Modified Davis classification, color fundus image, NIDEK AFC-230.
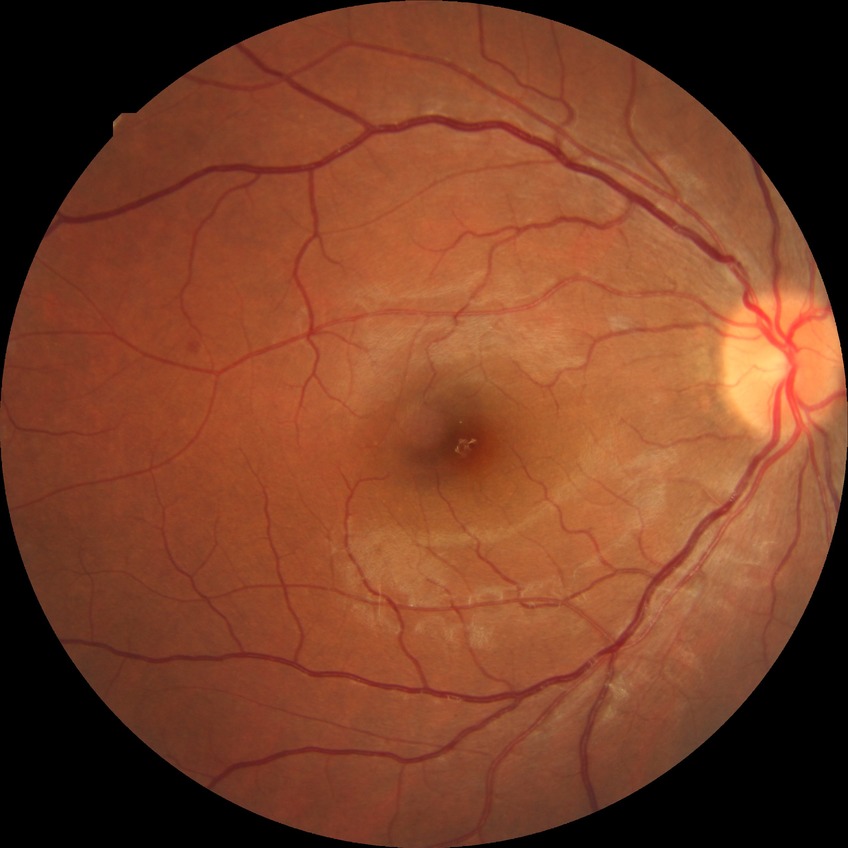
DR grade = PPDR.